Macula-centered. Mydriatic (tropicamide phenylephrine 1.0%). Acquired with a Topcon TRC-NW8
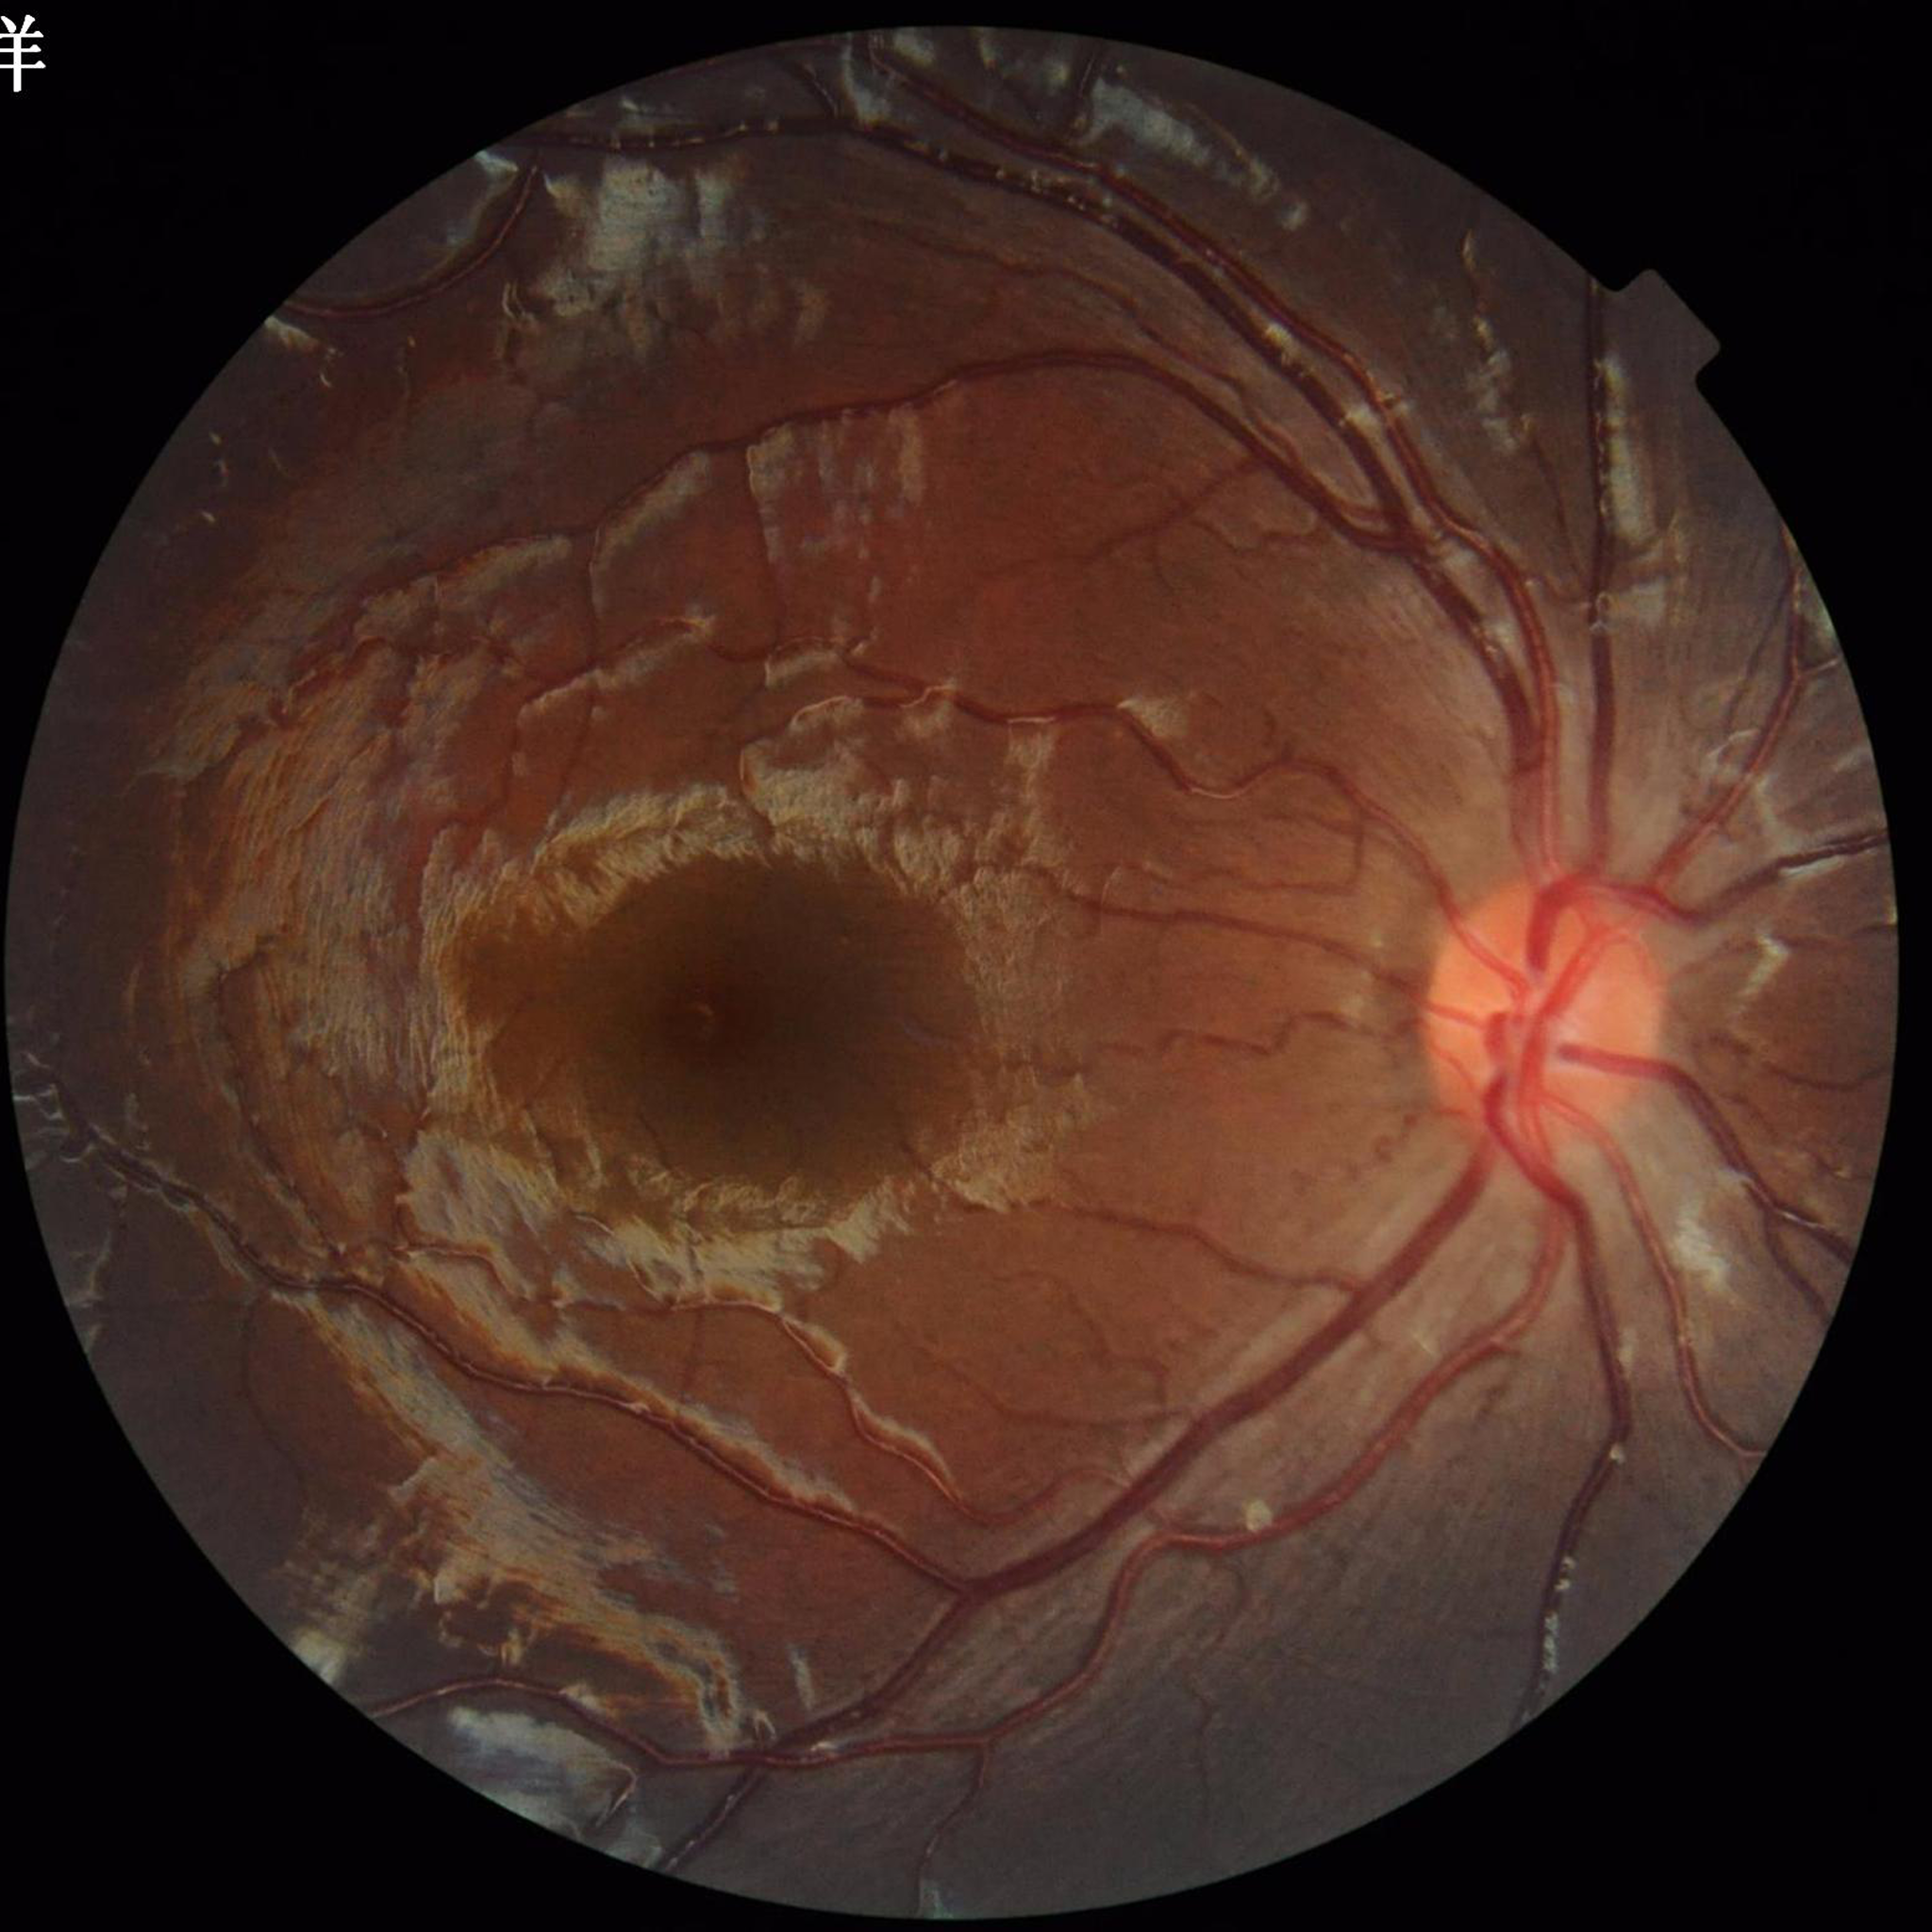

Impression: no AMD, diabetic retinopathy, or glaucoma.